RetCam wide-field infant fundus image; image size 1440x1080: 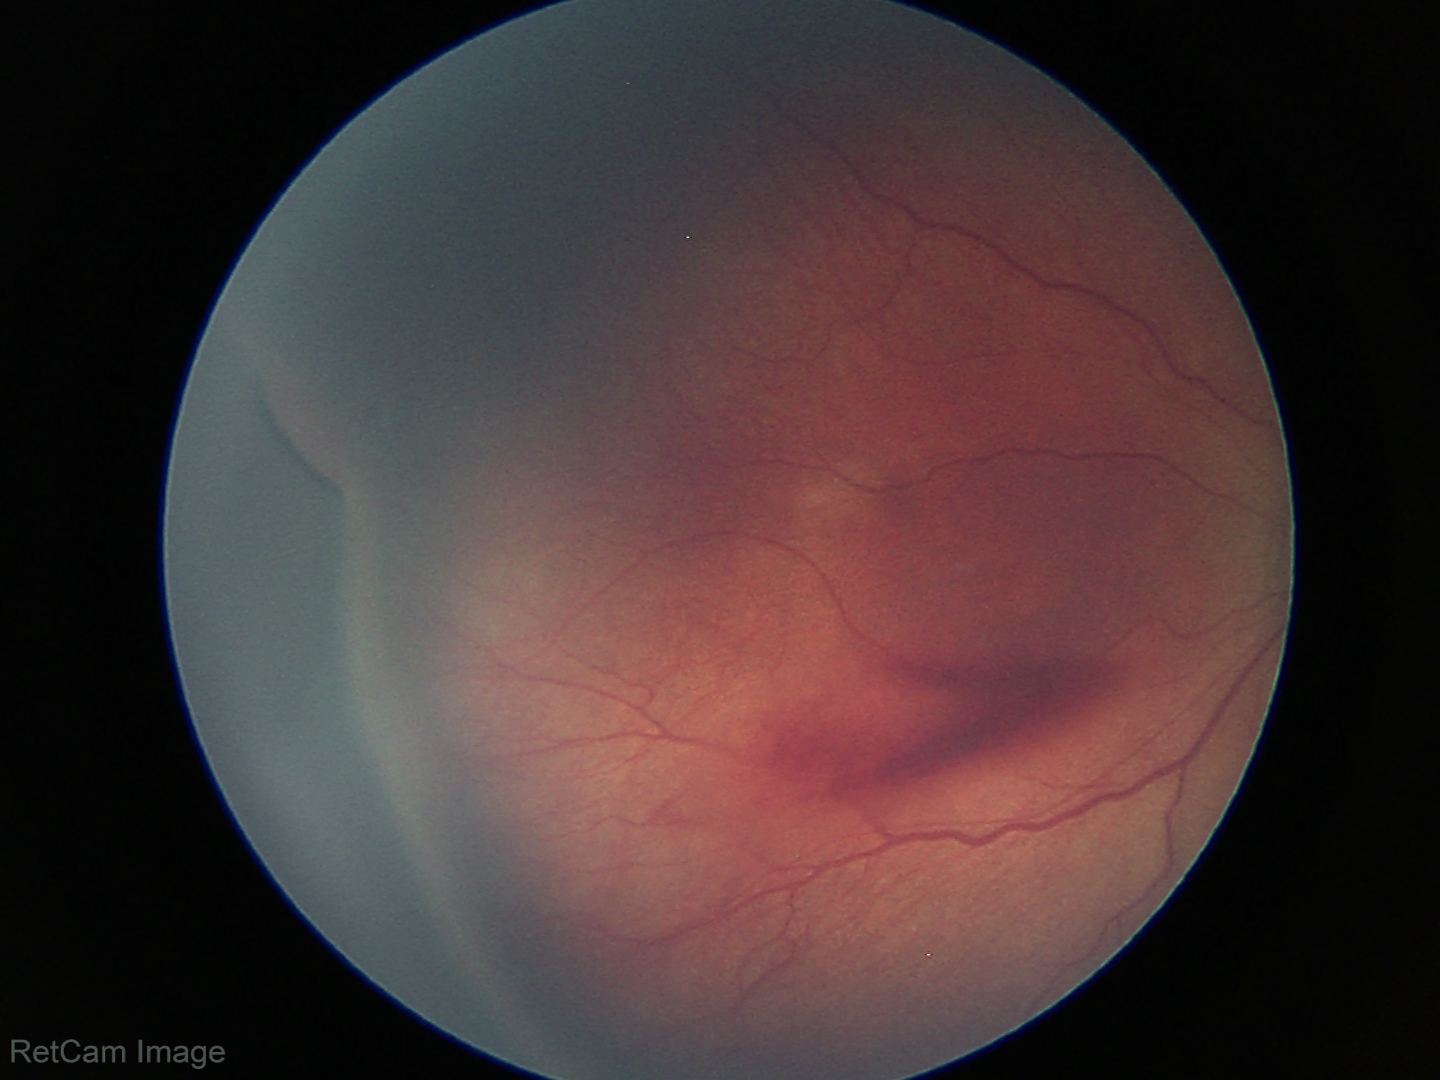

Examination diagnosed as ROP stage 3 — ridge with extraretinal fibrovascular proliferation.